NIDEK AFC-230; image size 848x848
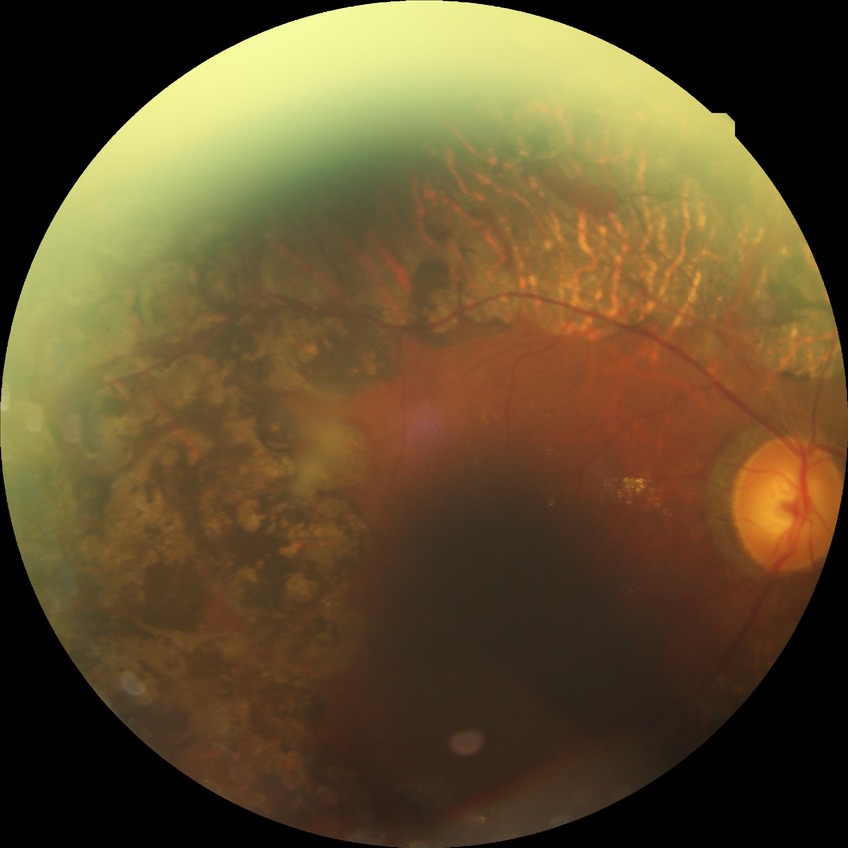
  davis_grade: proliferative diabetic retinopathy